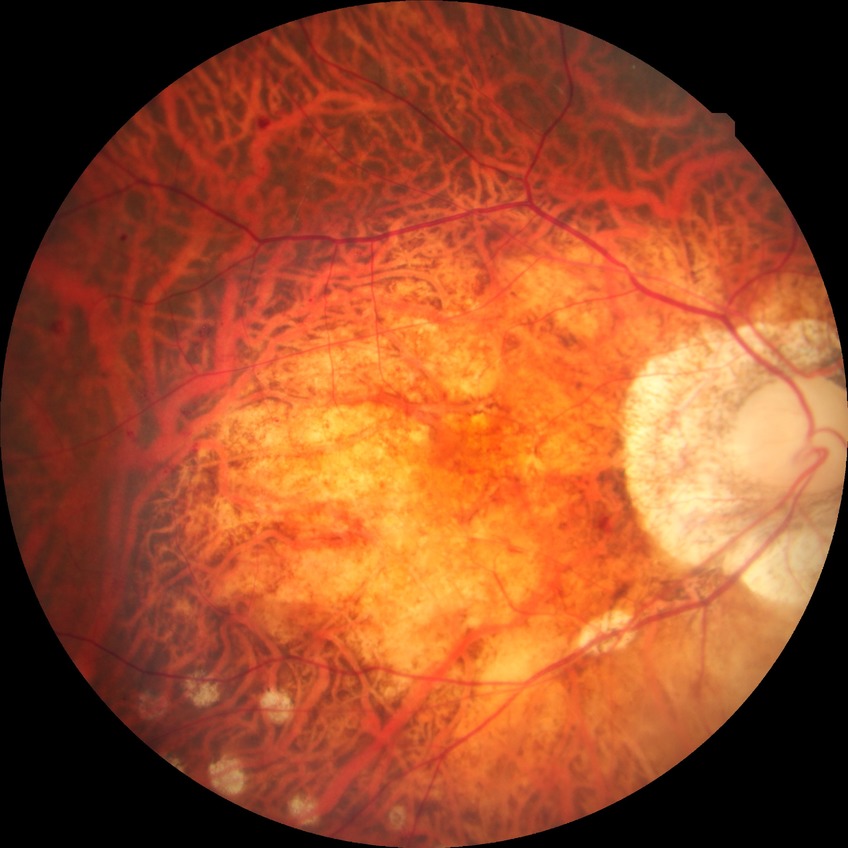
Davis stage: PDR.